Fundus photograph cropped around the optic nerve head.
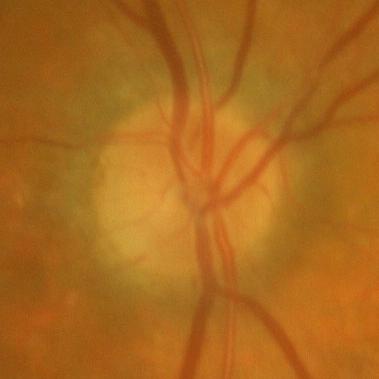

Showing no glaucomatous damage.